Macula-centered, pupil-dilated, color fundus image: 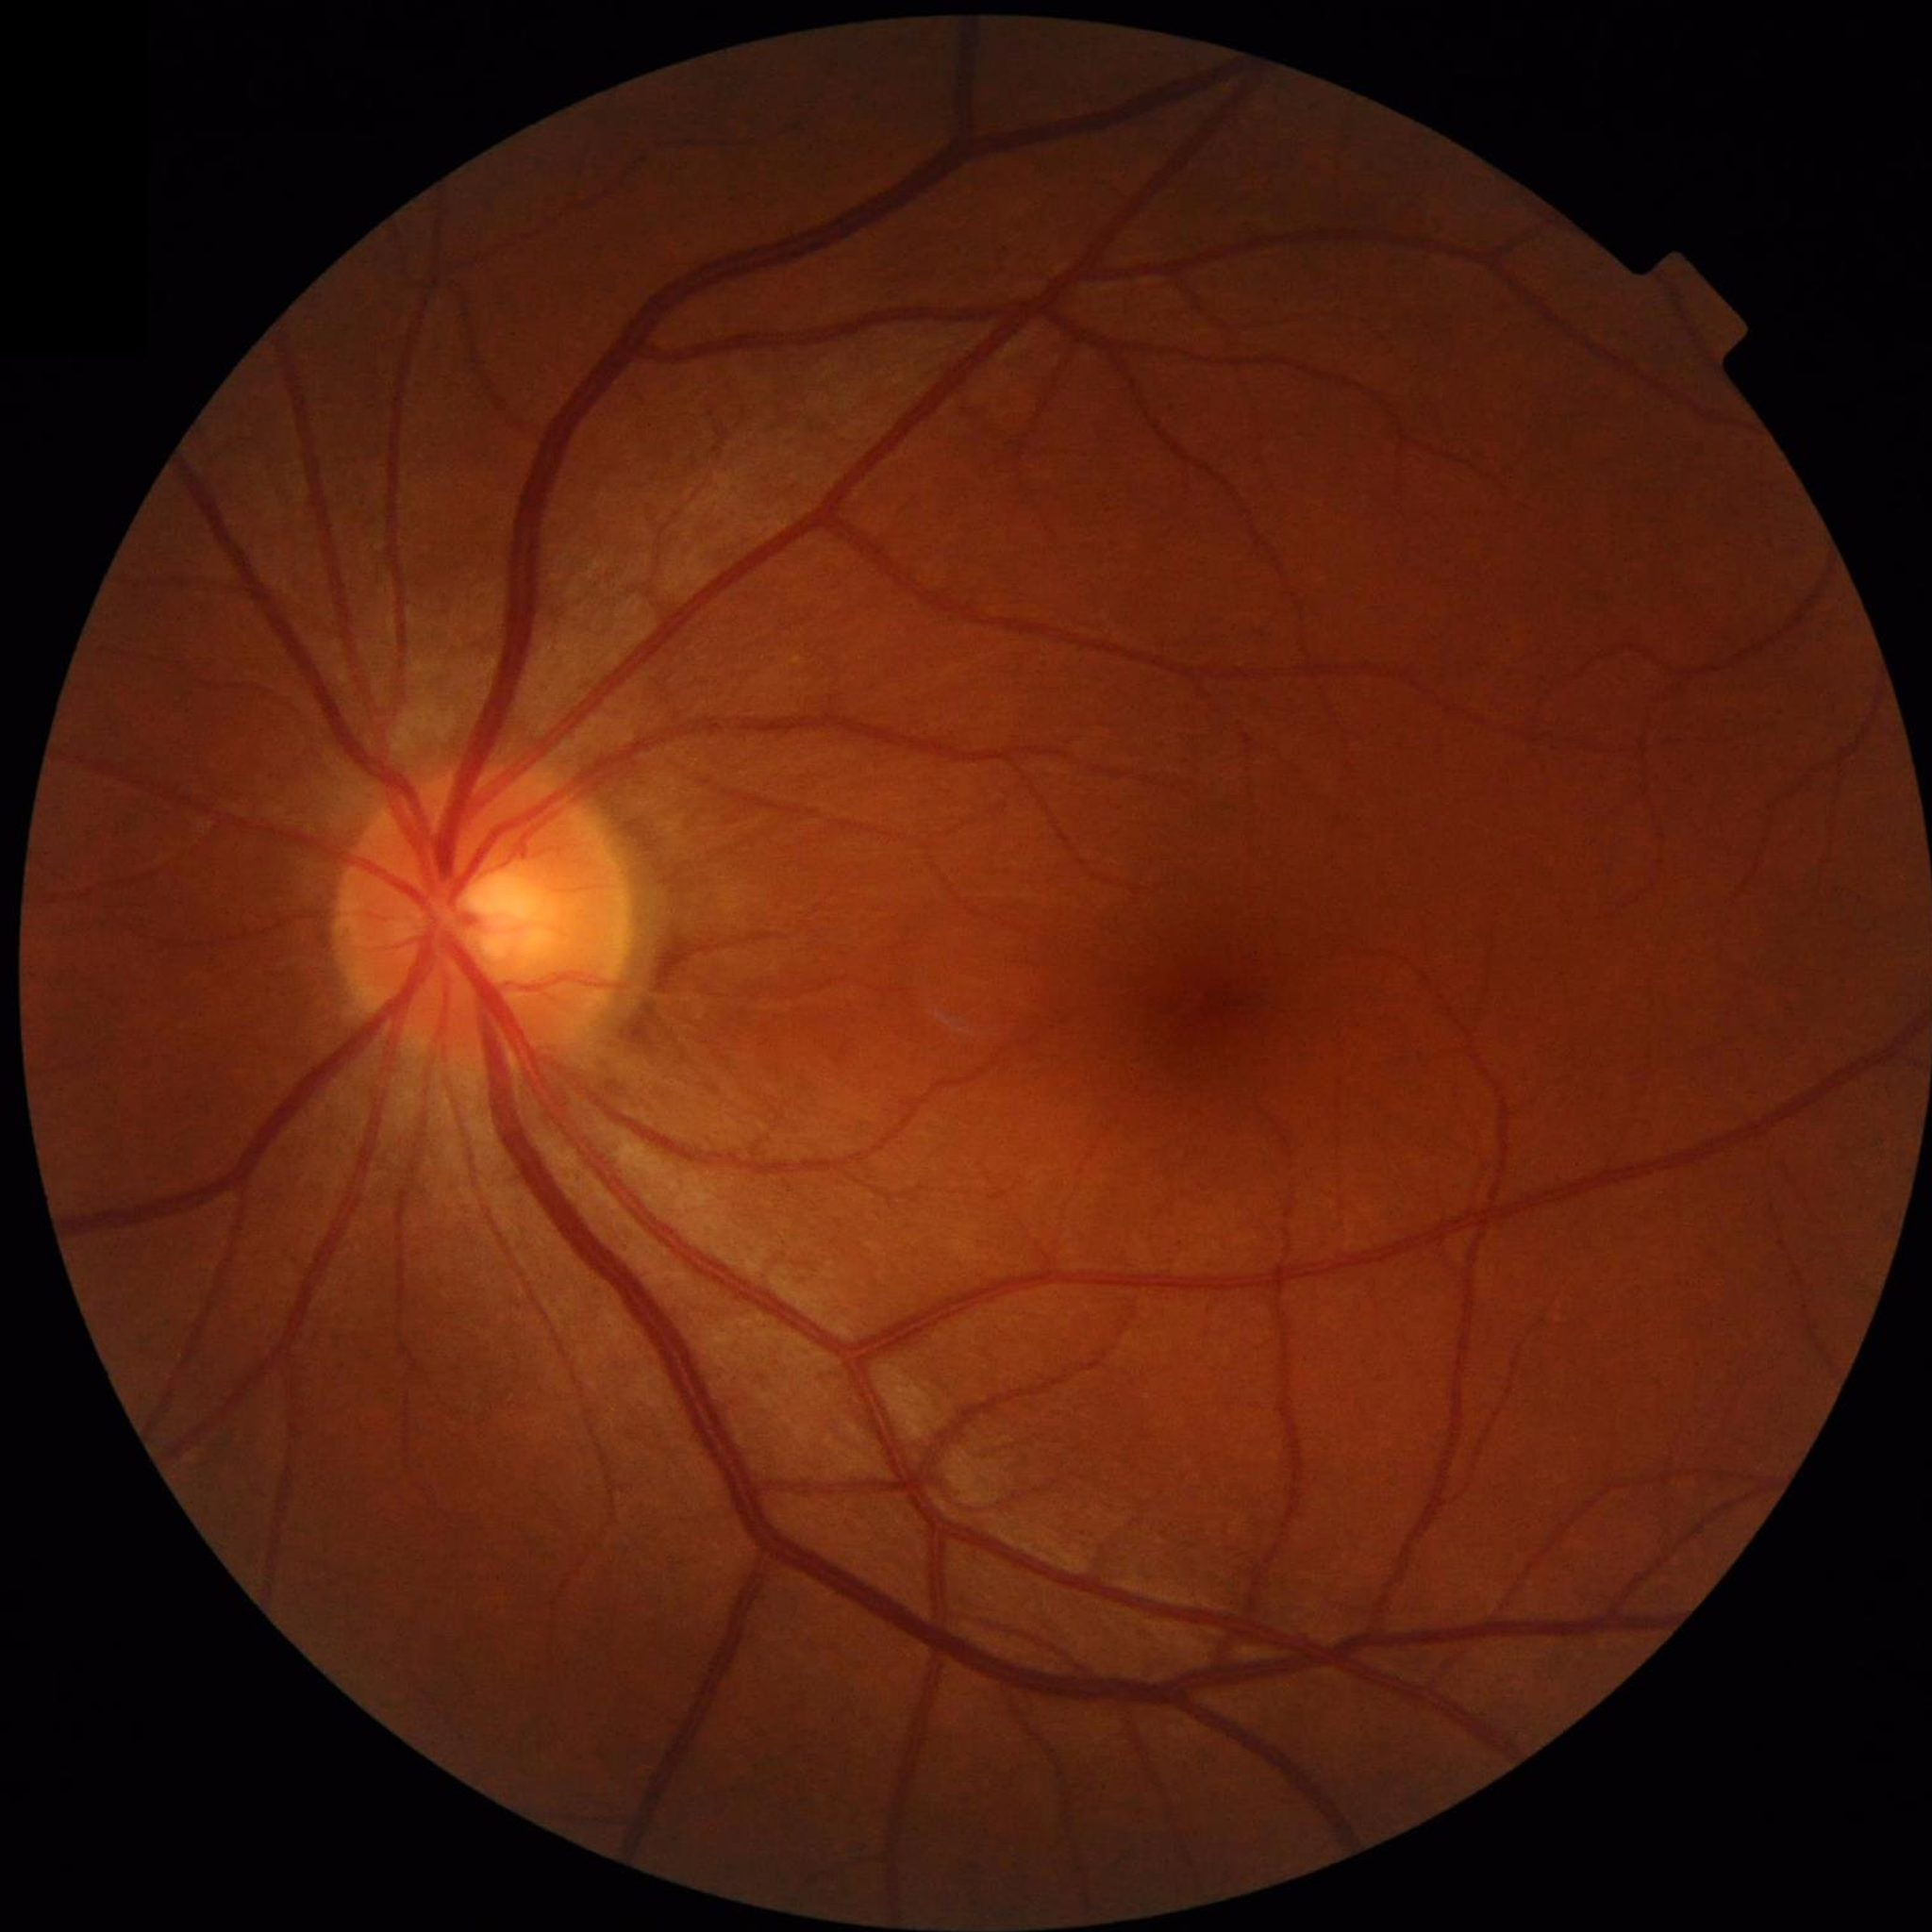 No findings of AMD, diabetic retinopathy, or glaucoma.
Quality assessment: no blur, contrast adequate, illumination and color satisfactory.